Posterior pole photograph. Modified Davis grading
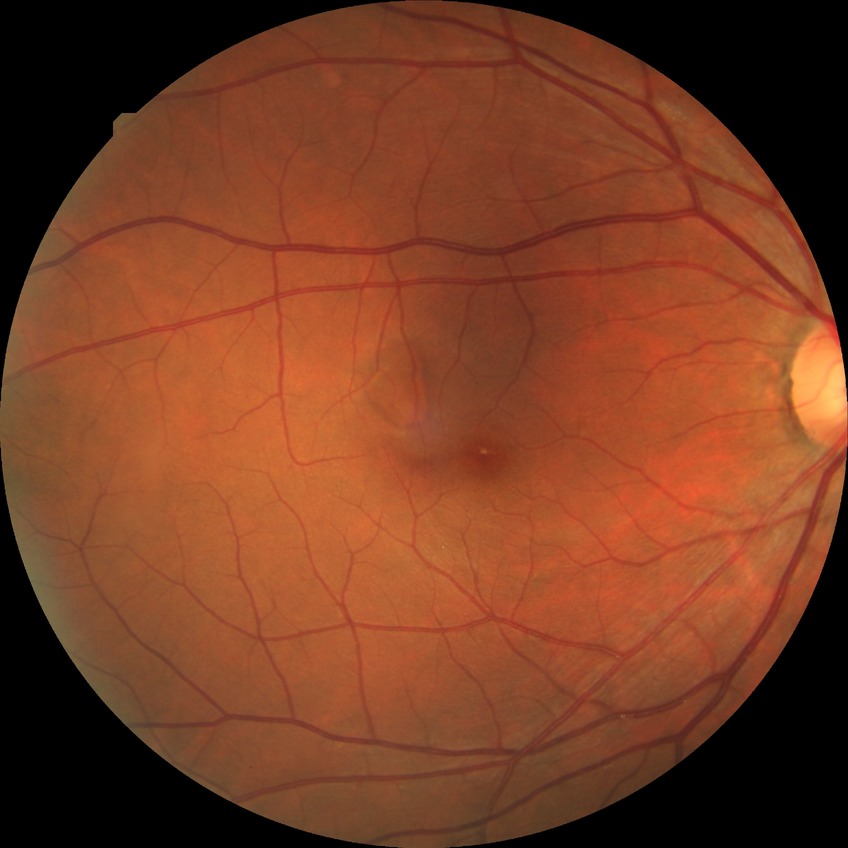

  davis_grade: NDR (no diabetic retinopathy)